848 x 848 pixels. NIDEK AFC-230:
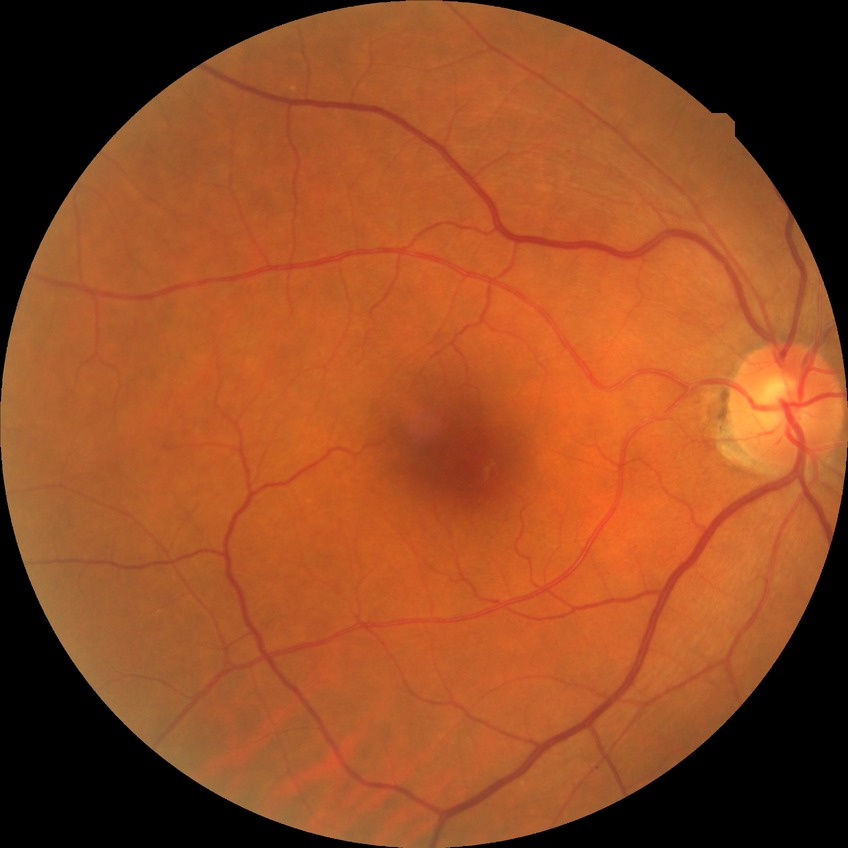 Diabetic retinopathy (DR): NDR (no diabetic retinopathy).